848 by 848 pixels, FOV: 45 degrees.
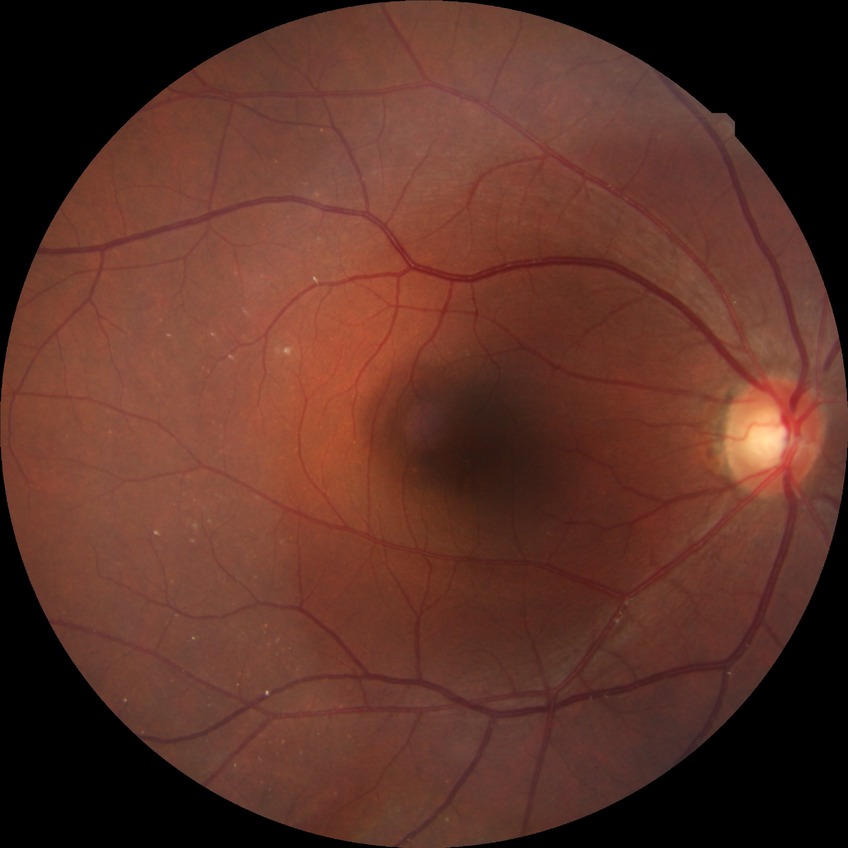 {
  "davis_grade": "NDR (no diabetic retinopathy)"
}